Acquired on the Phoenix ICON; wide-field fundus image from infant ROP screening: 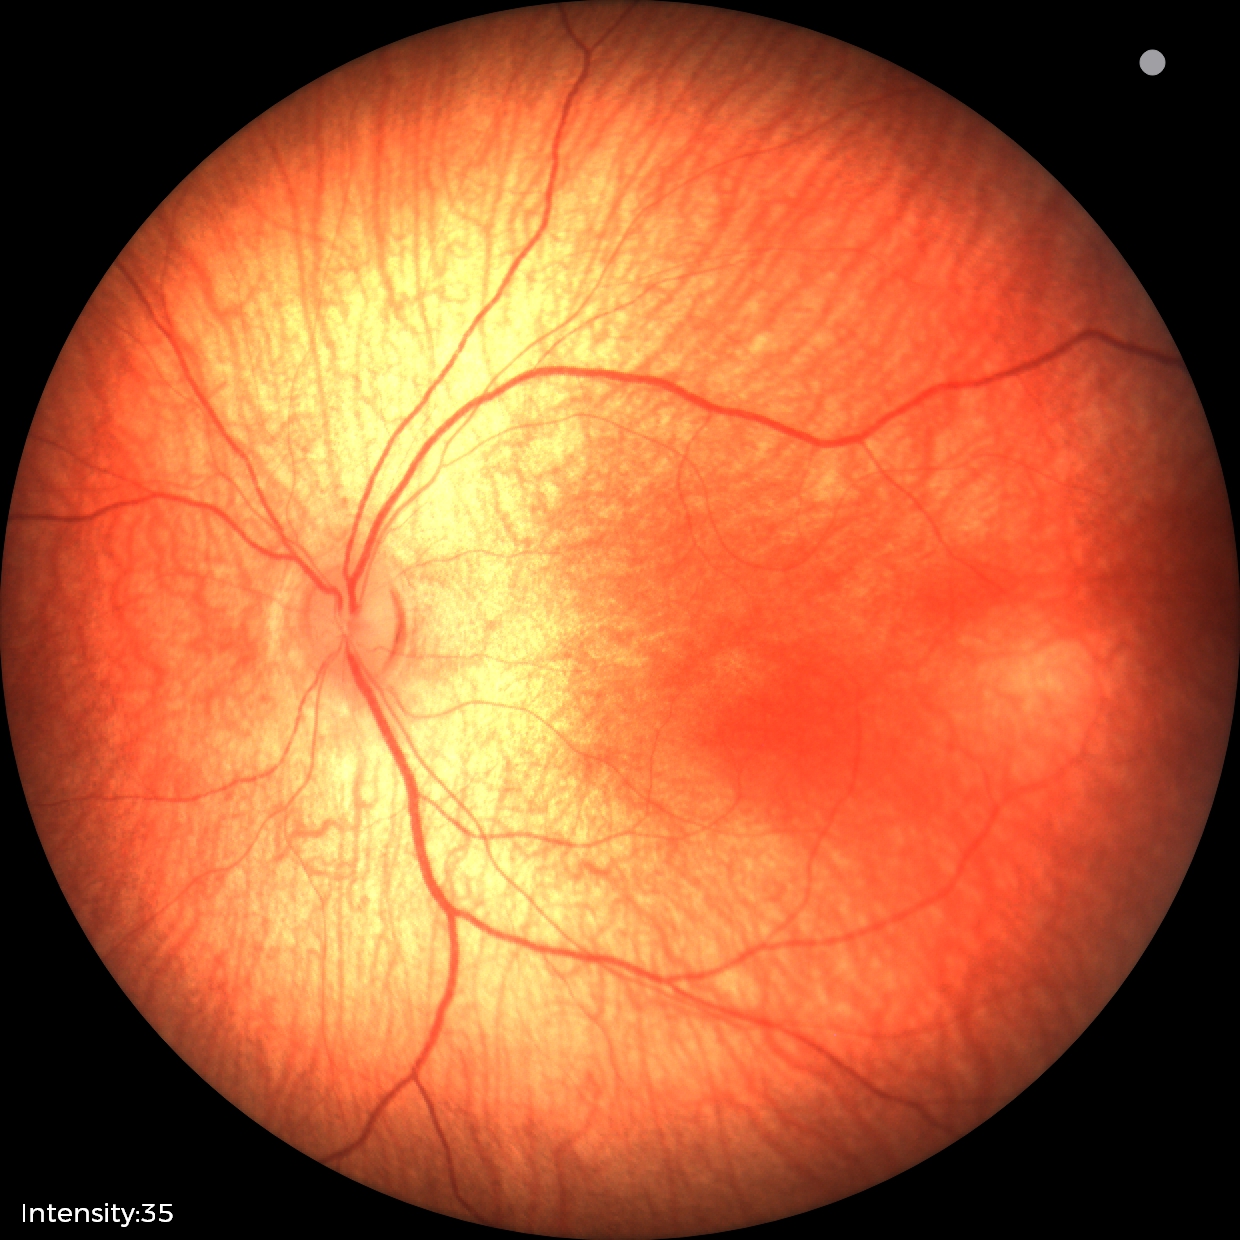 Impression: physiological retinal finding.